CFP; NIDEK AFC-230 fundus camera: 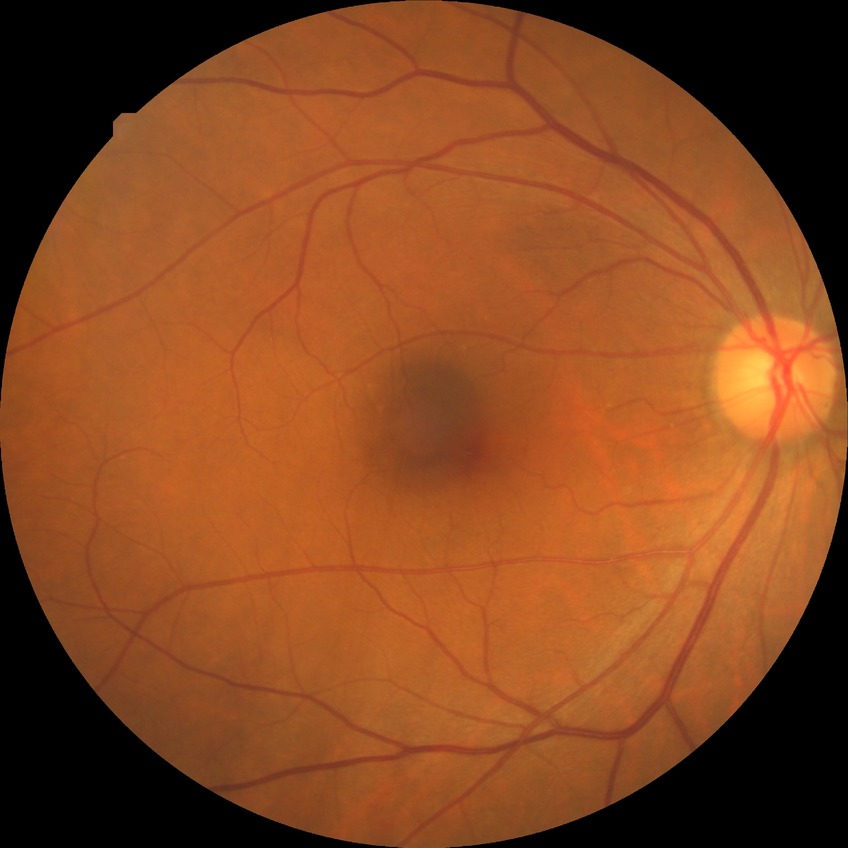

diabetic retinopathy (DR): NDR (no diabetic retinopathy).